1240 x 1240 pixels · Phoenix ICON, 100° FOV · pediatric retinal photograph (wide-field).
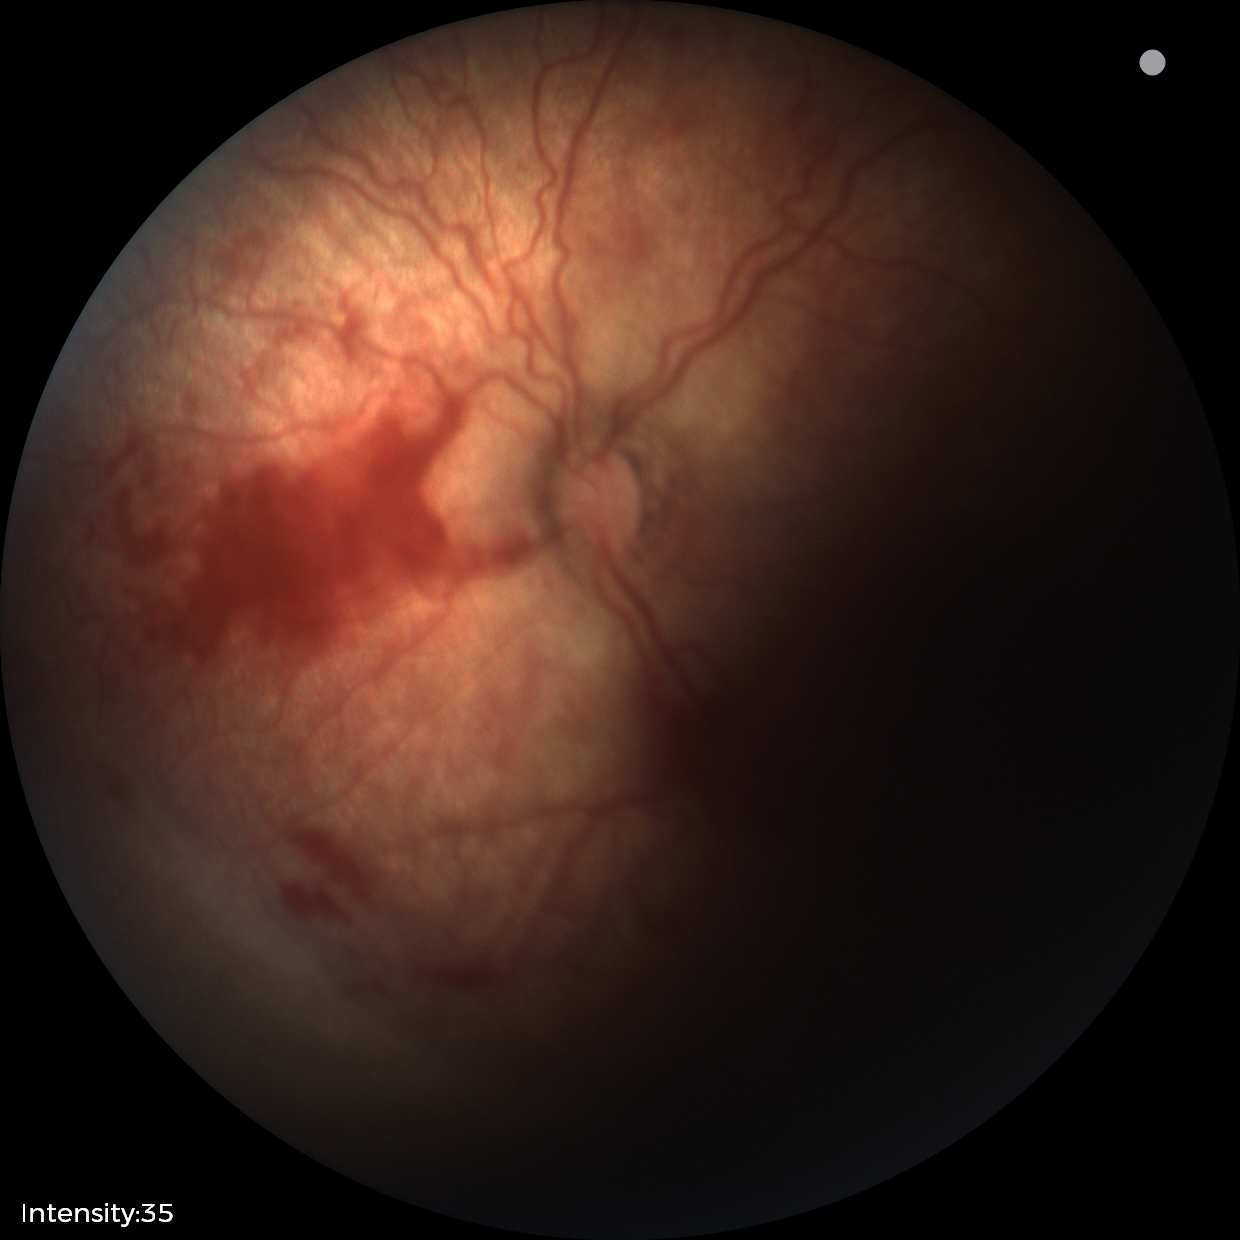
Diagnosis from this screening exam: retinopathy of prematurity stage 2 — ridge with height and width at the demarcation line.